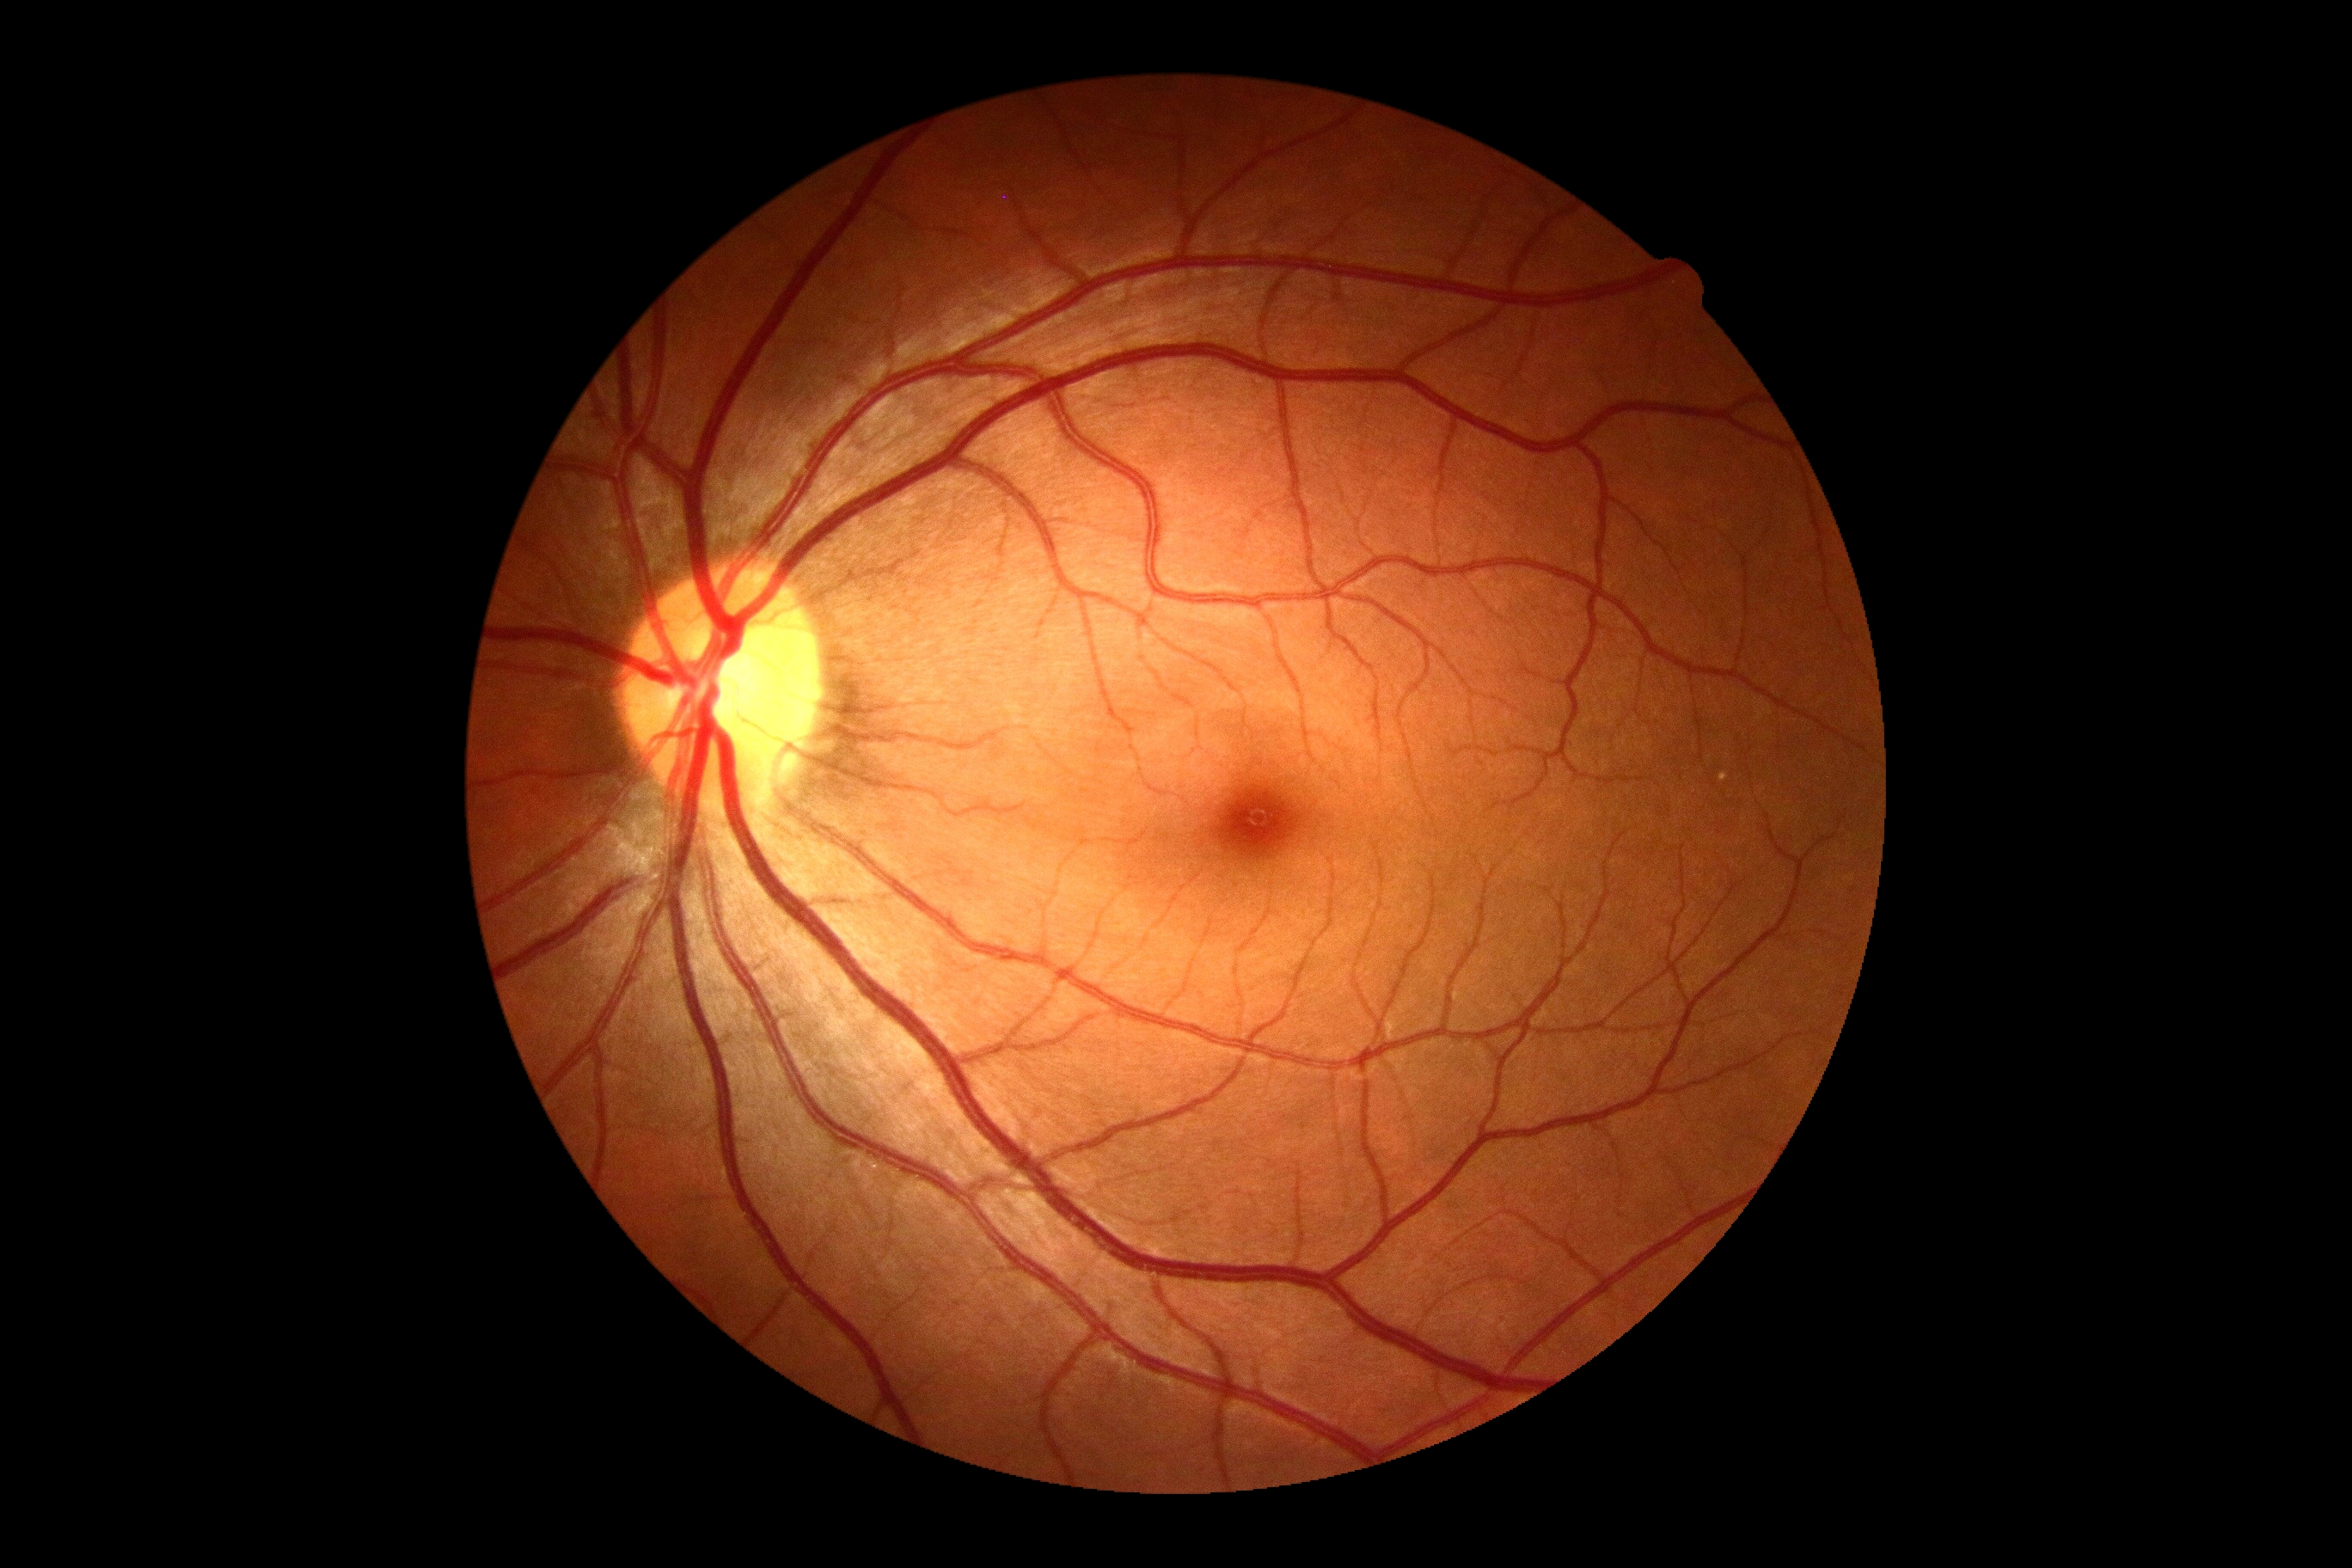

DR severity: no apparent diabetic retinopathy (grade 0).